Wide-field contact fundus photograph of an infant; camera: Phoenix ICON (100° FOV):
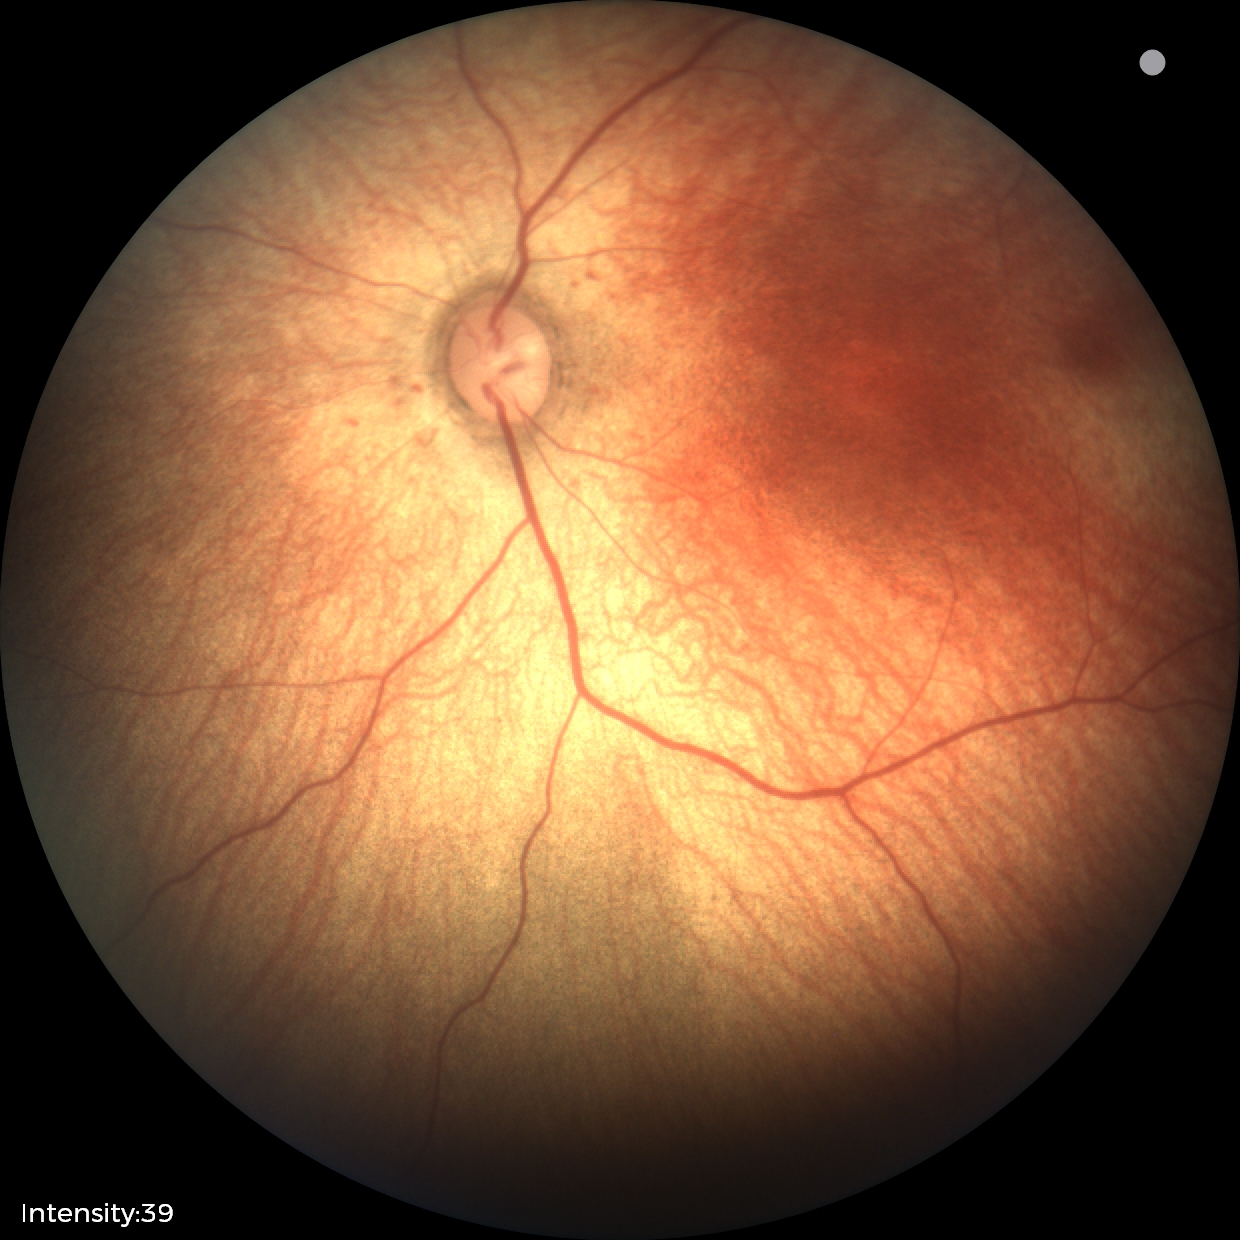 Examination with physiological retinal findings.